45° field of view · fundus photo · 2352x1568px
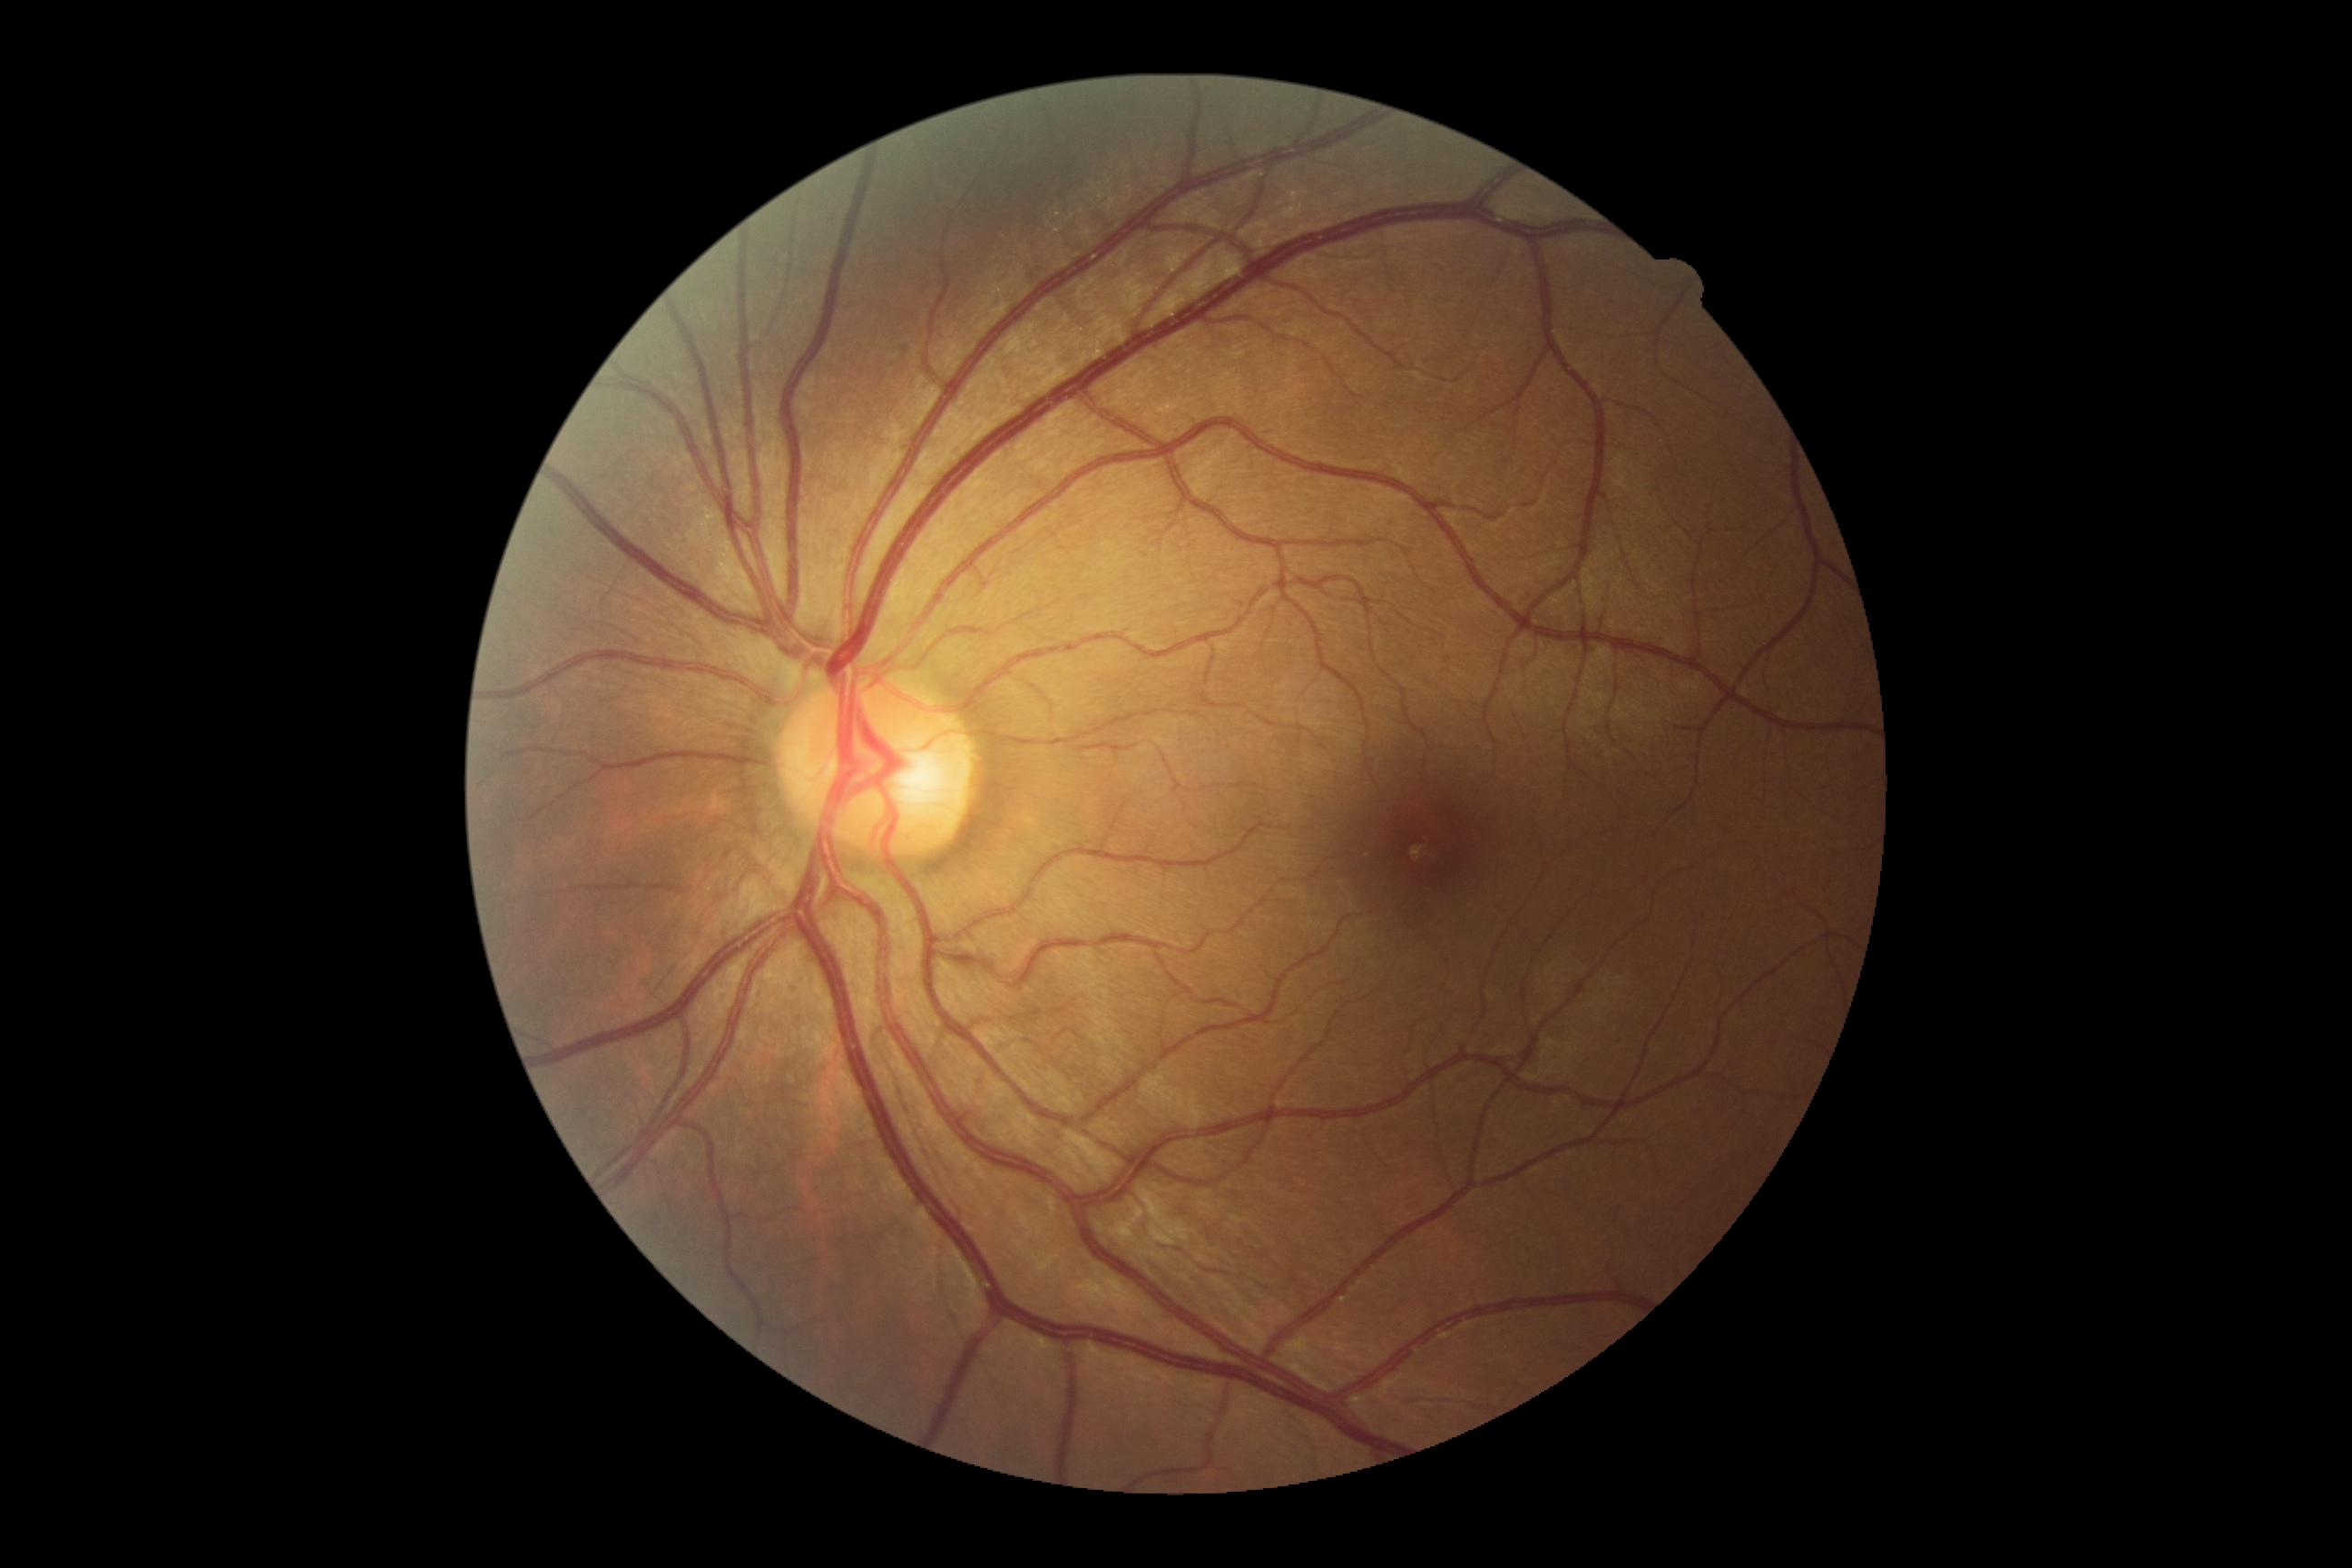
DR grade = 0.